Color fundus image, camera: Topcon TRC-50DX:
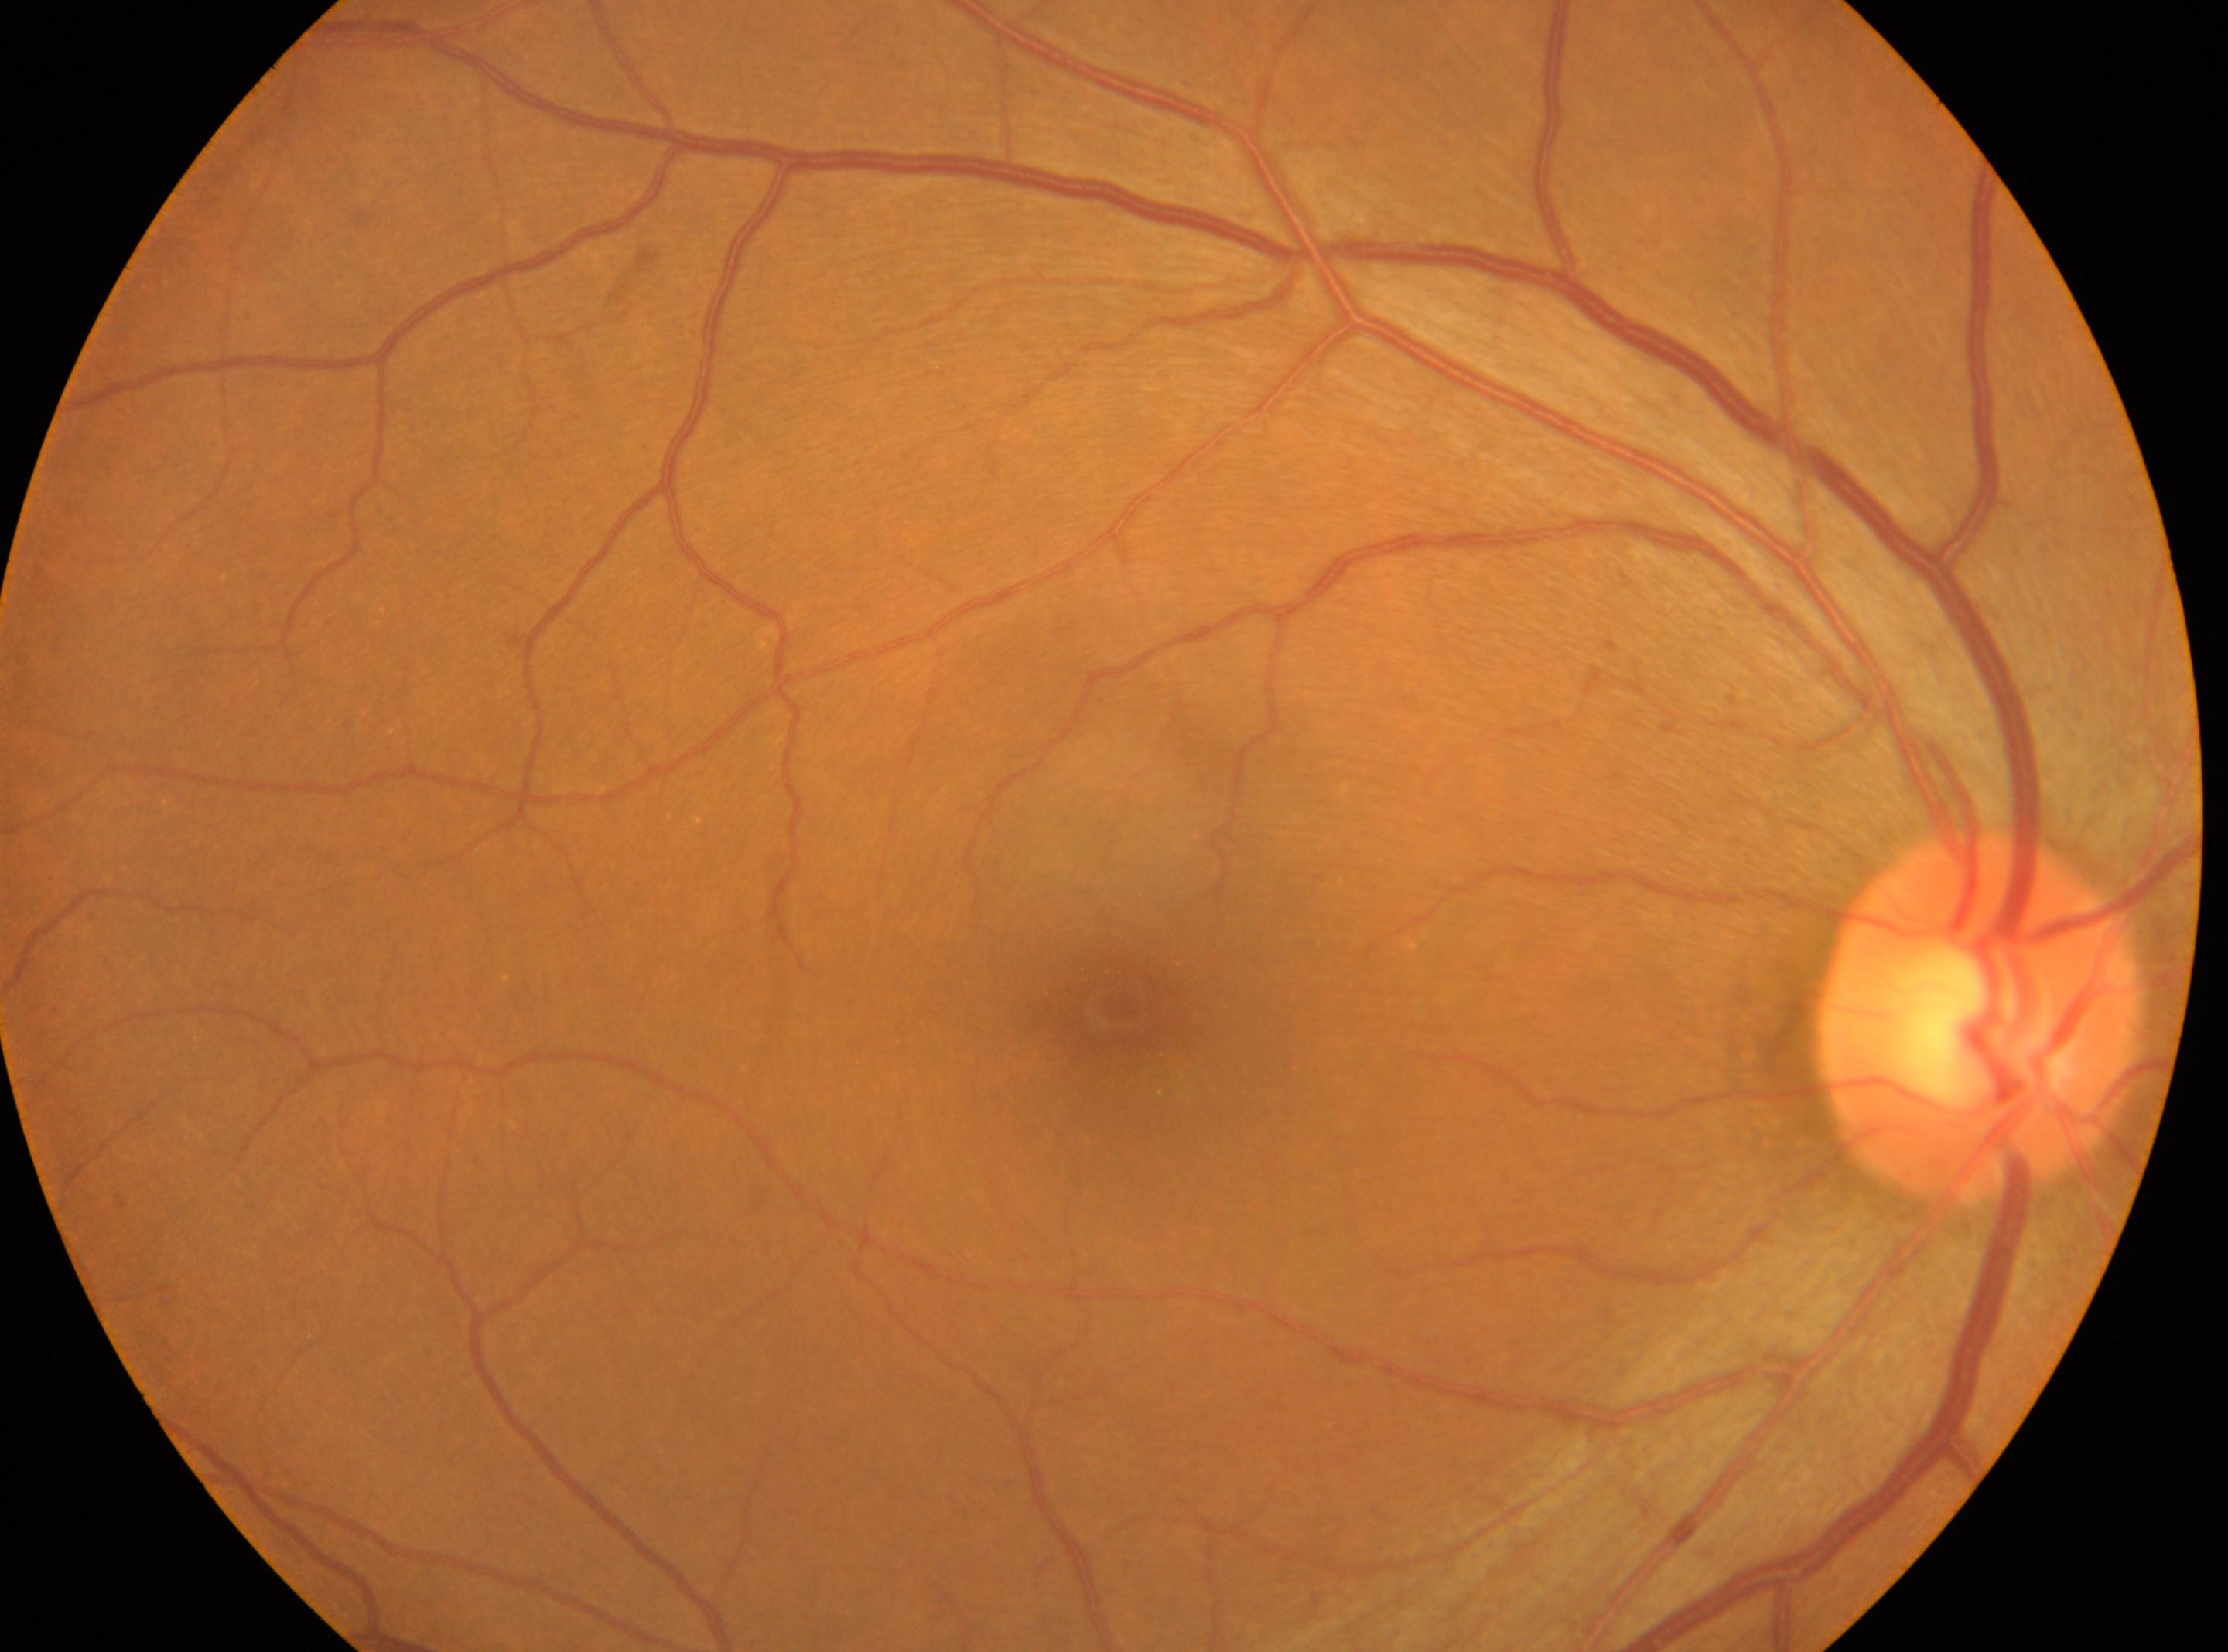

laterality = oculus dexter
fovea centralis = 1116, 1007
DR = grade 0
optic nerve head = 1980, 1016